Infant wide-field retinal image.
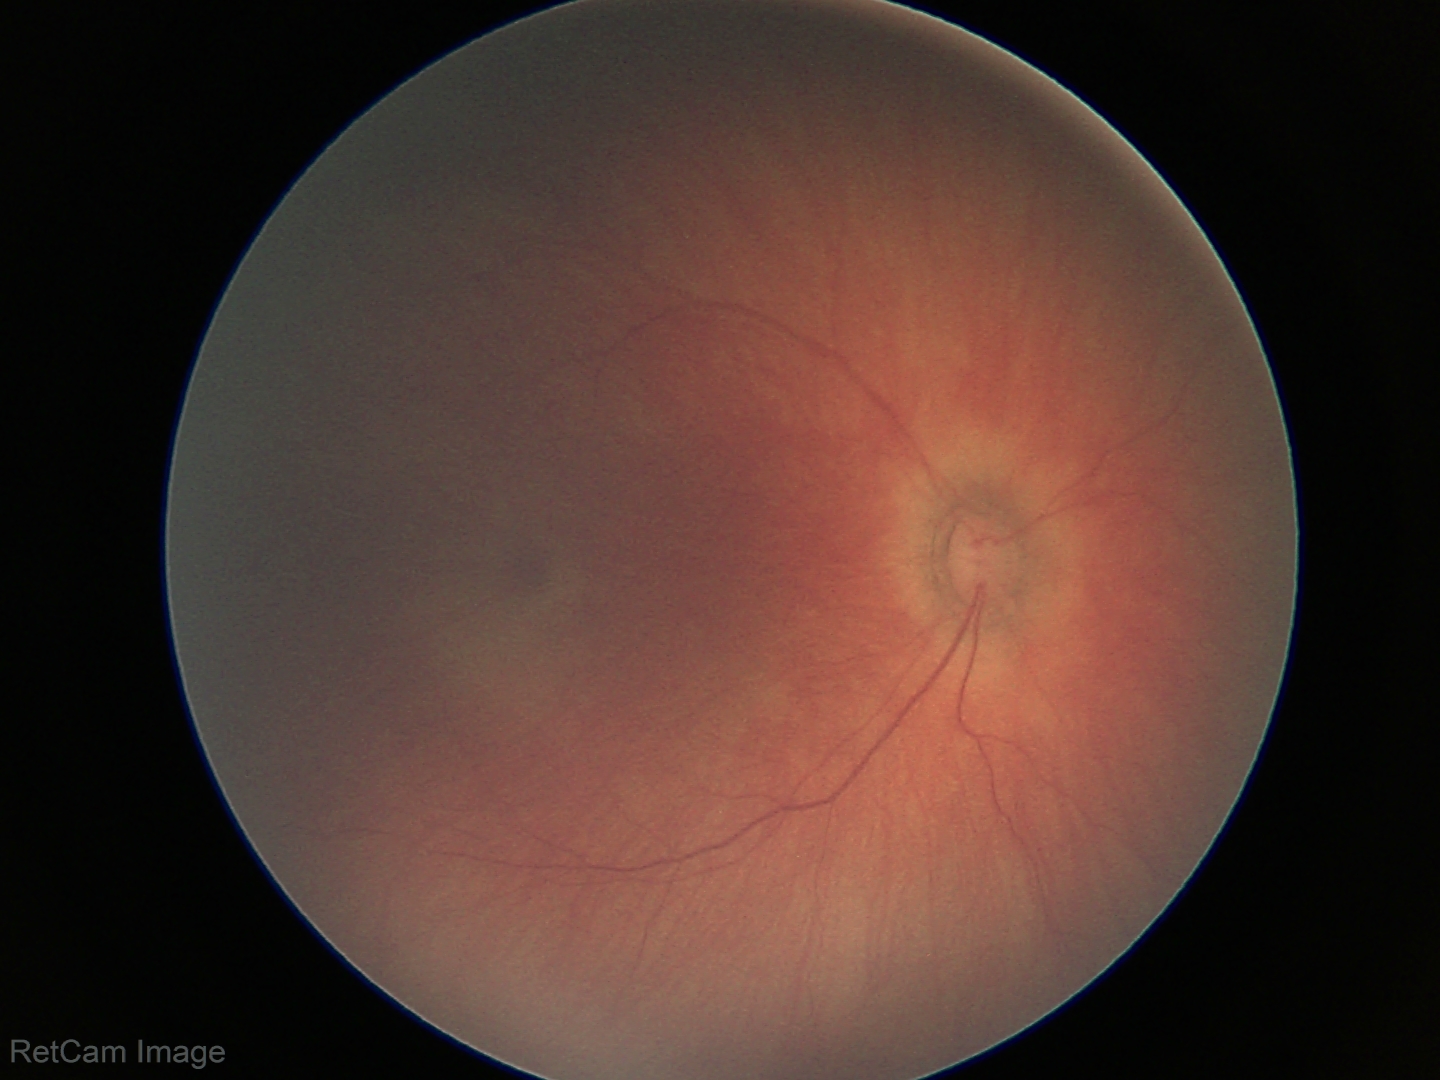
Screening examination with no abnormal retinal findings.